CFP
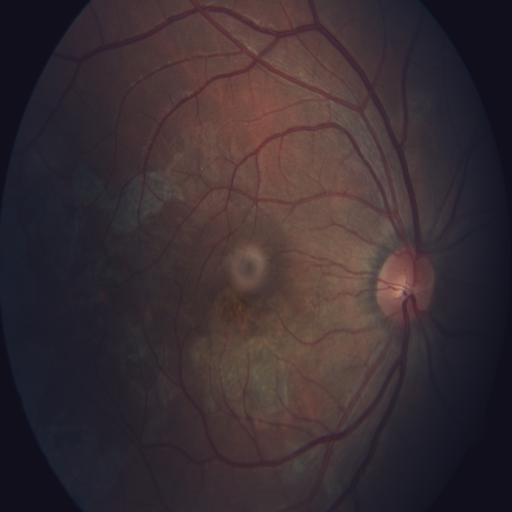 Showing chorioretinitis.